RetCam wide-field infant fundus image — 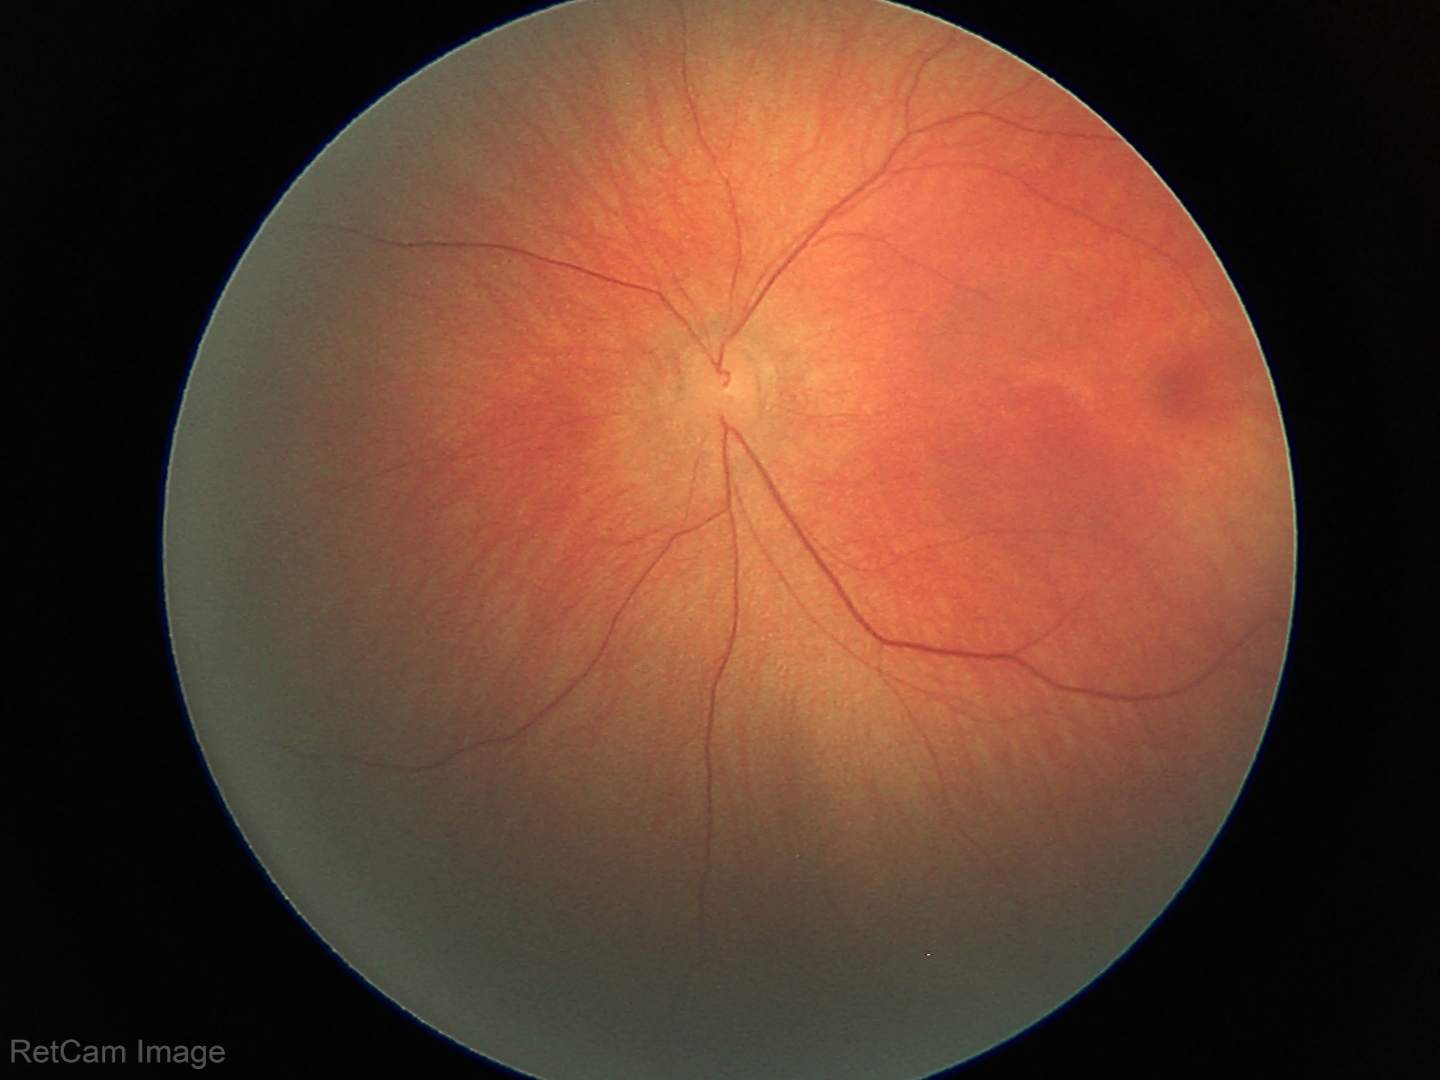 Screening examination with no abnormal retinal findings.